Nonmydriatic, NIDEK AFC-230 fundus camera, fundus photo, 848x848, 45 degree fundus photograph
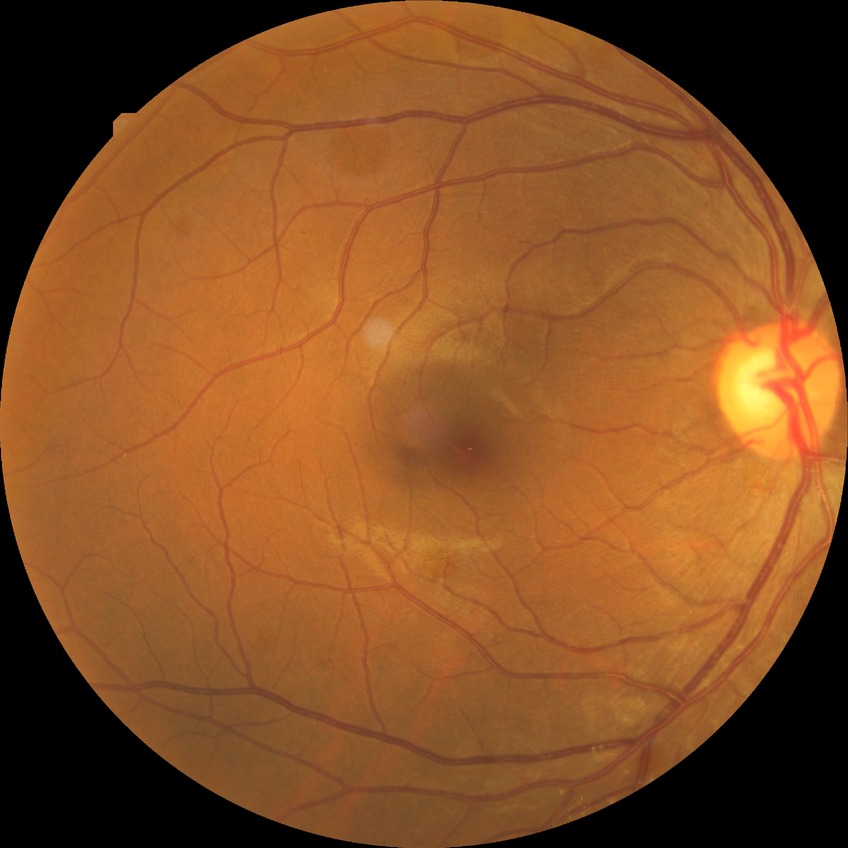
Diabetic retinopathy (DR) is no diabetic retinopathy (NDR).